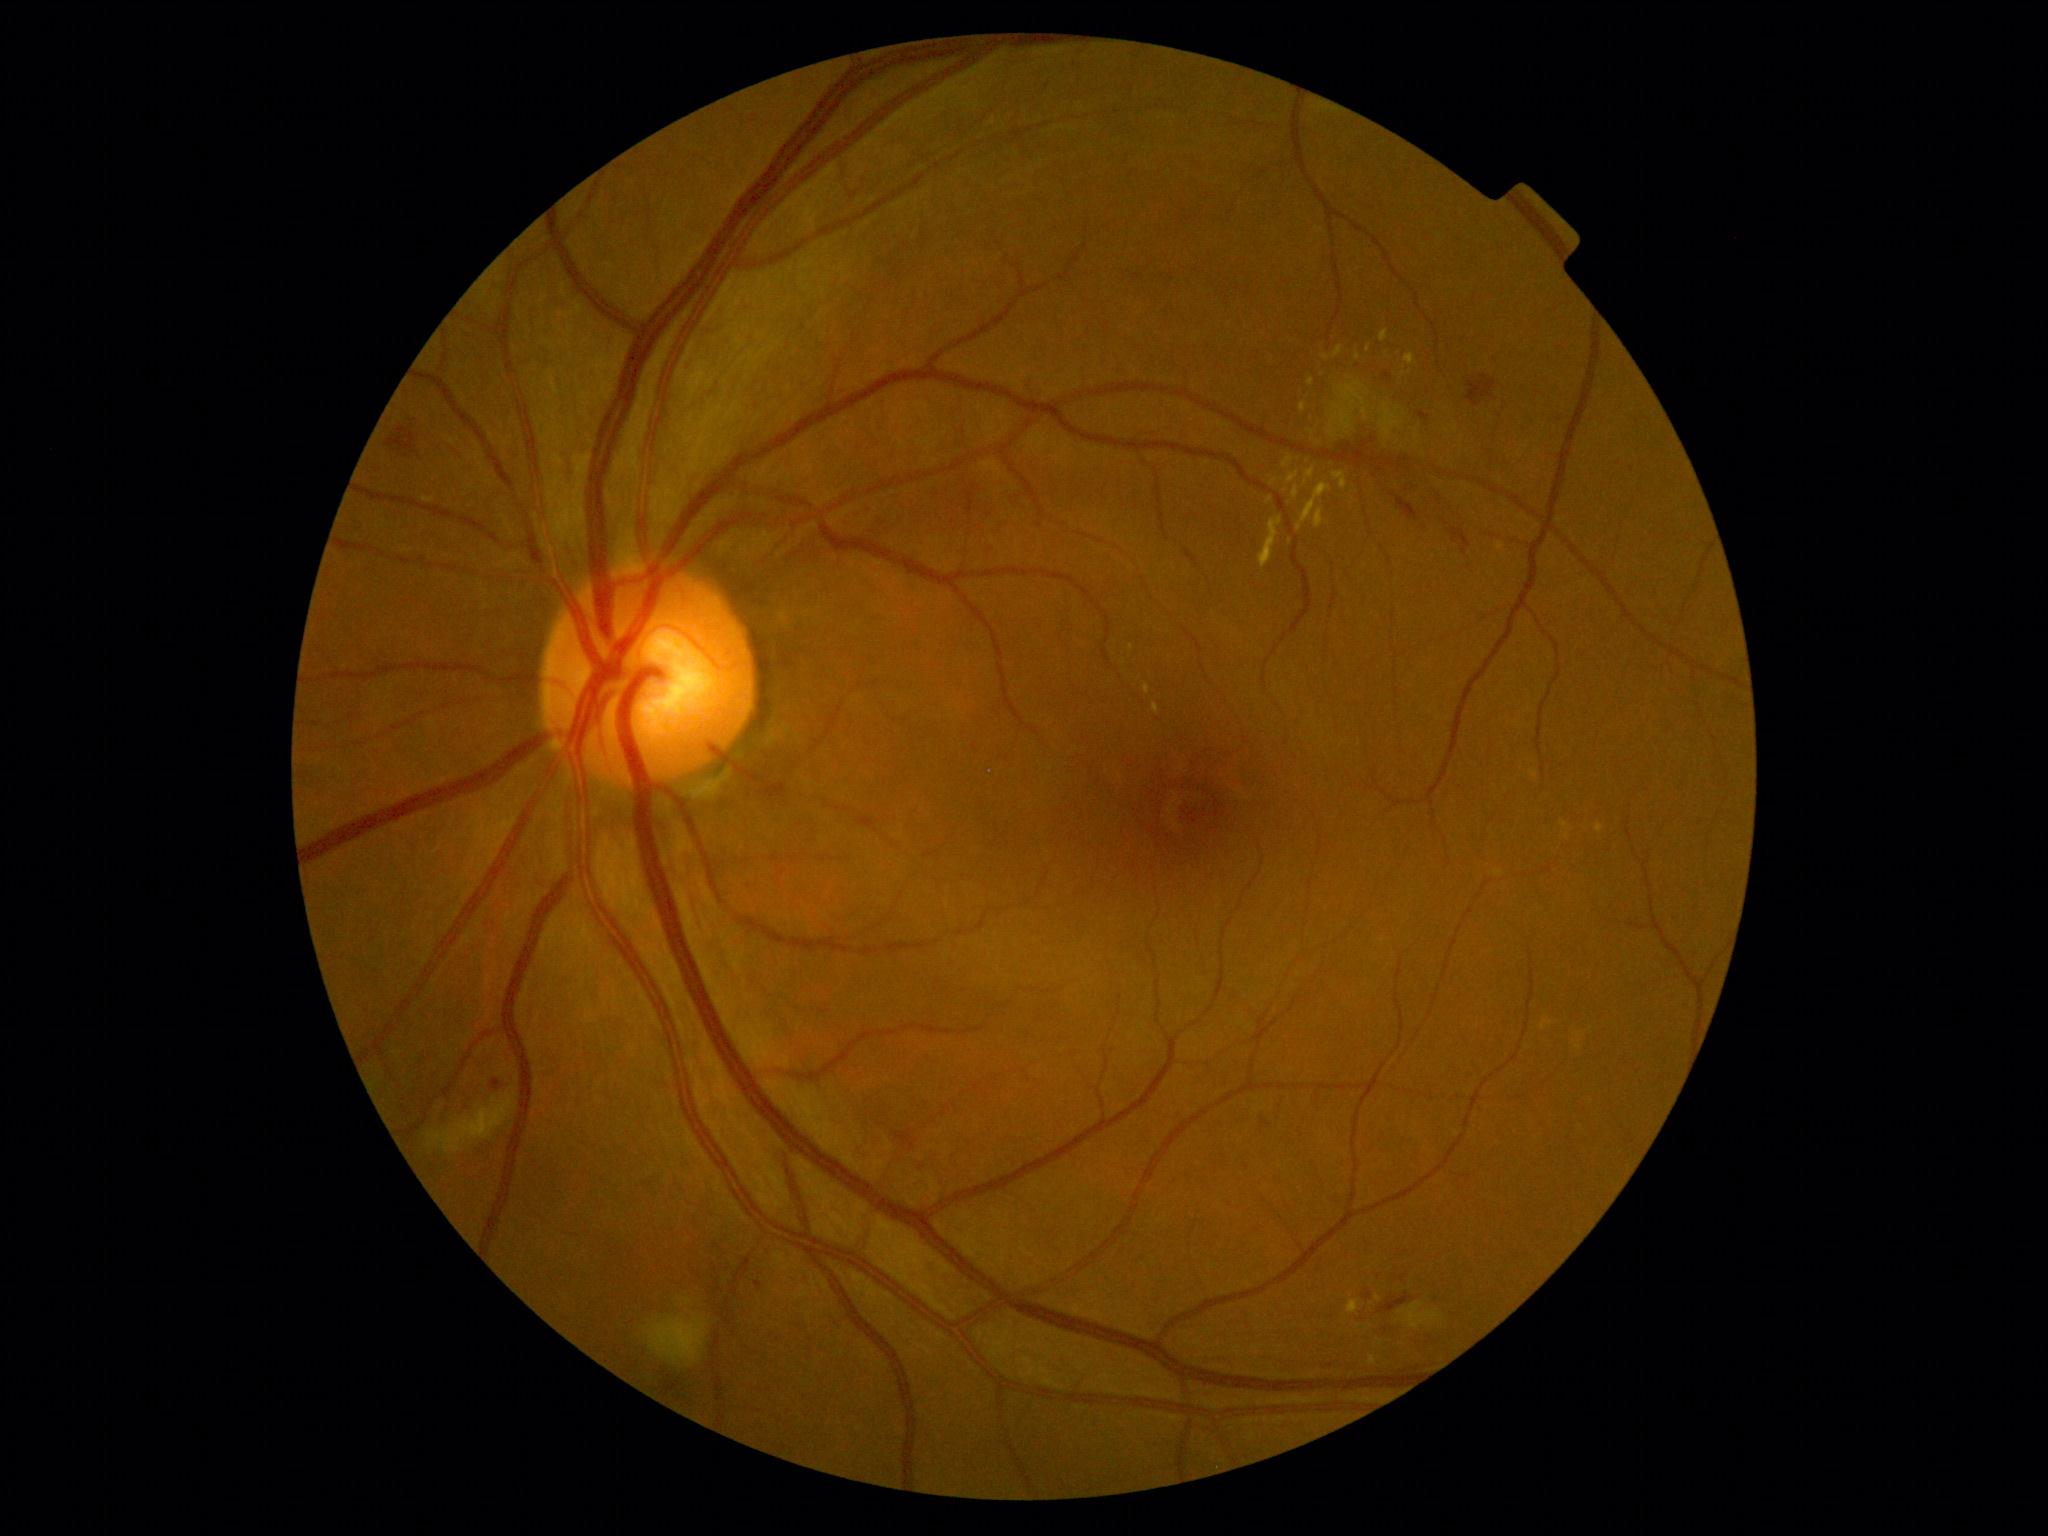 DR stage: grade 2 (moderate NPDR).